45° FOV: 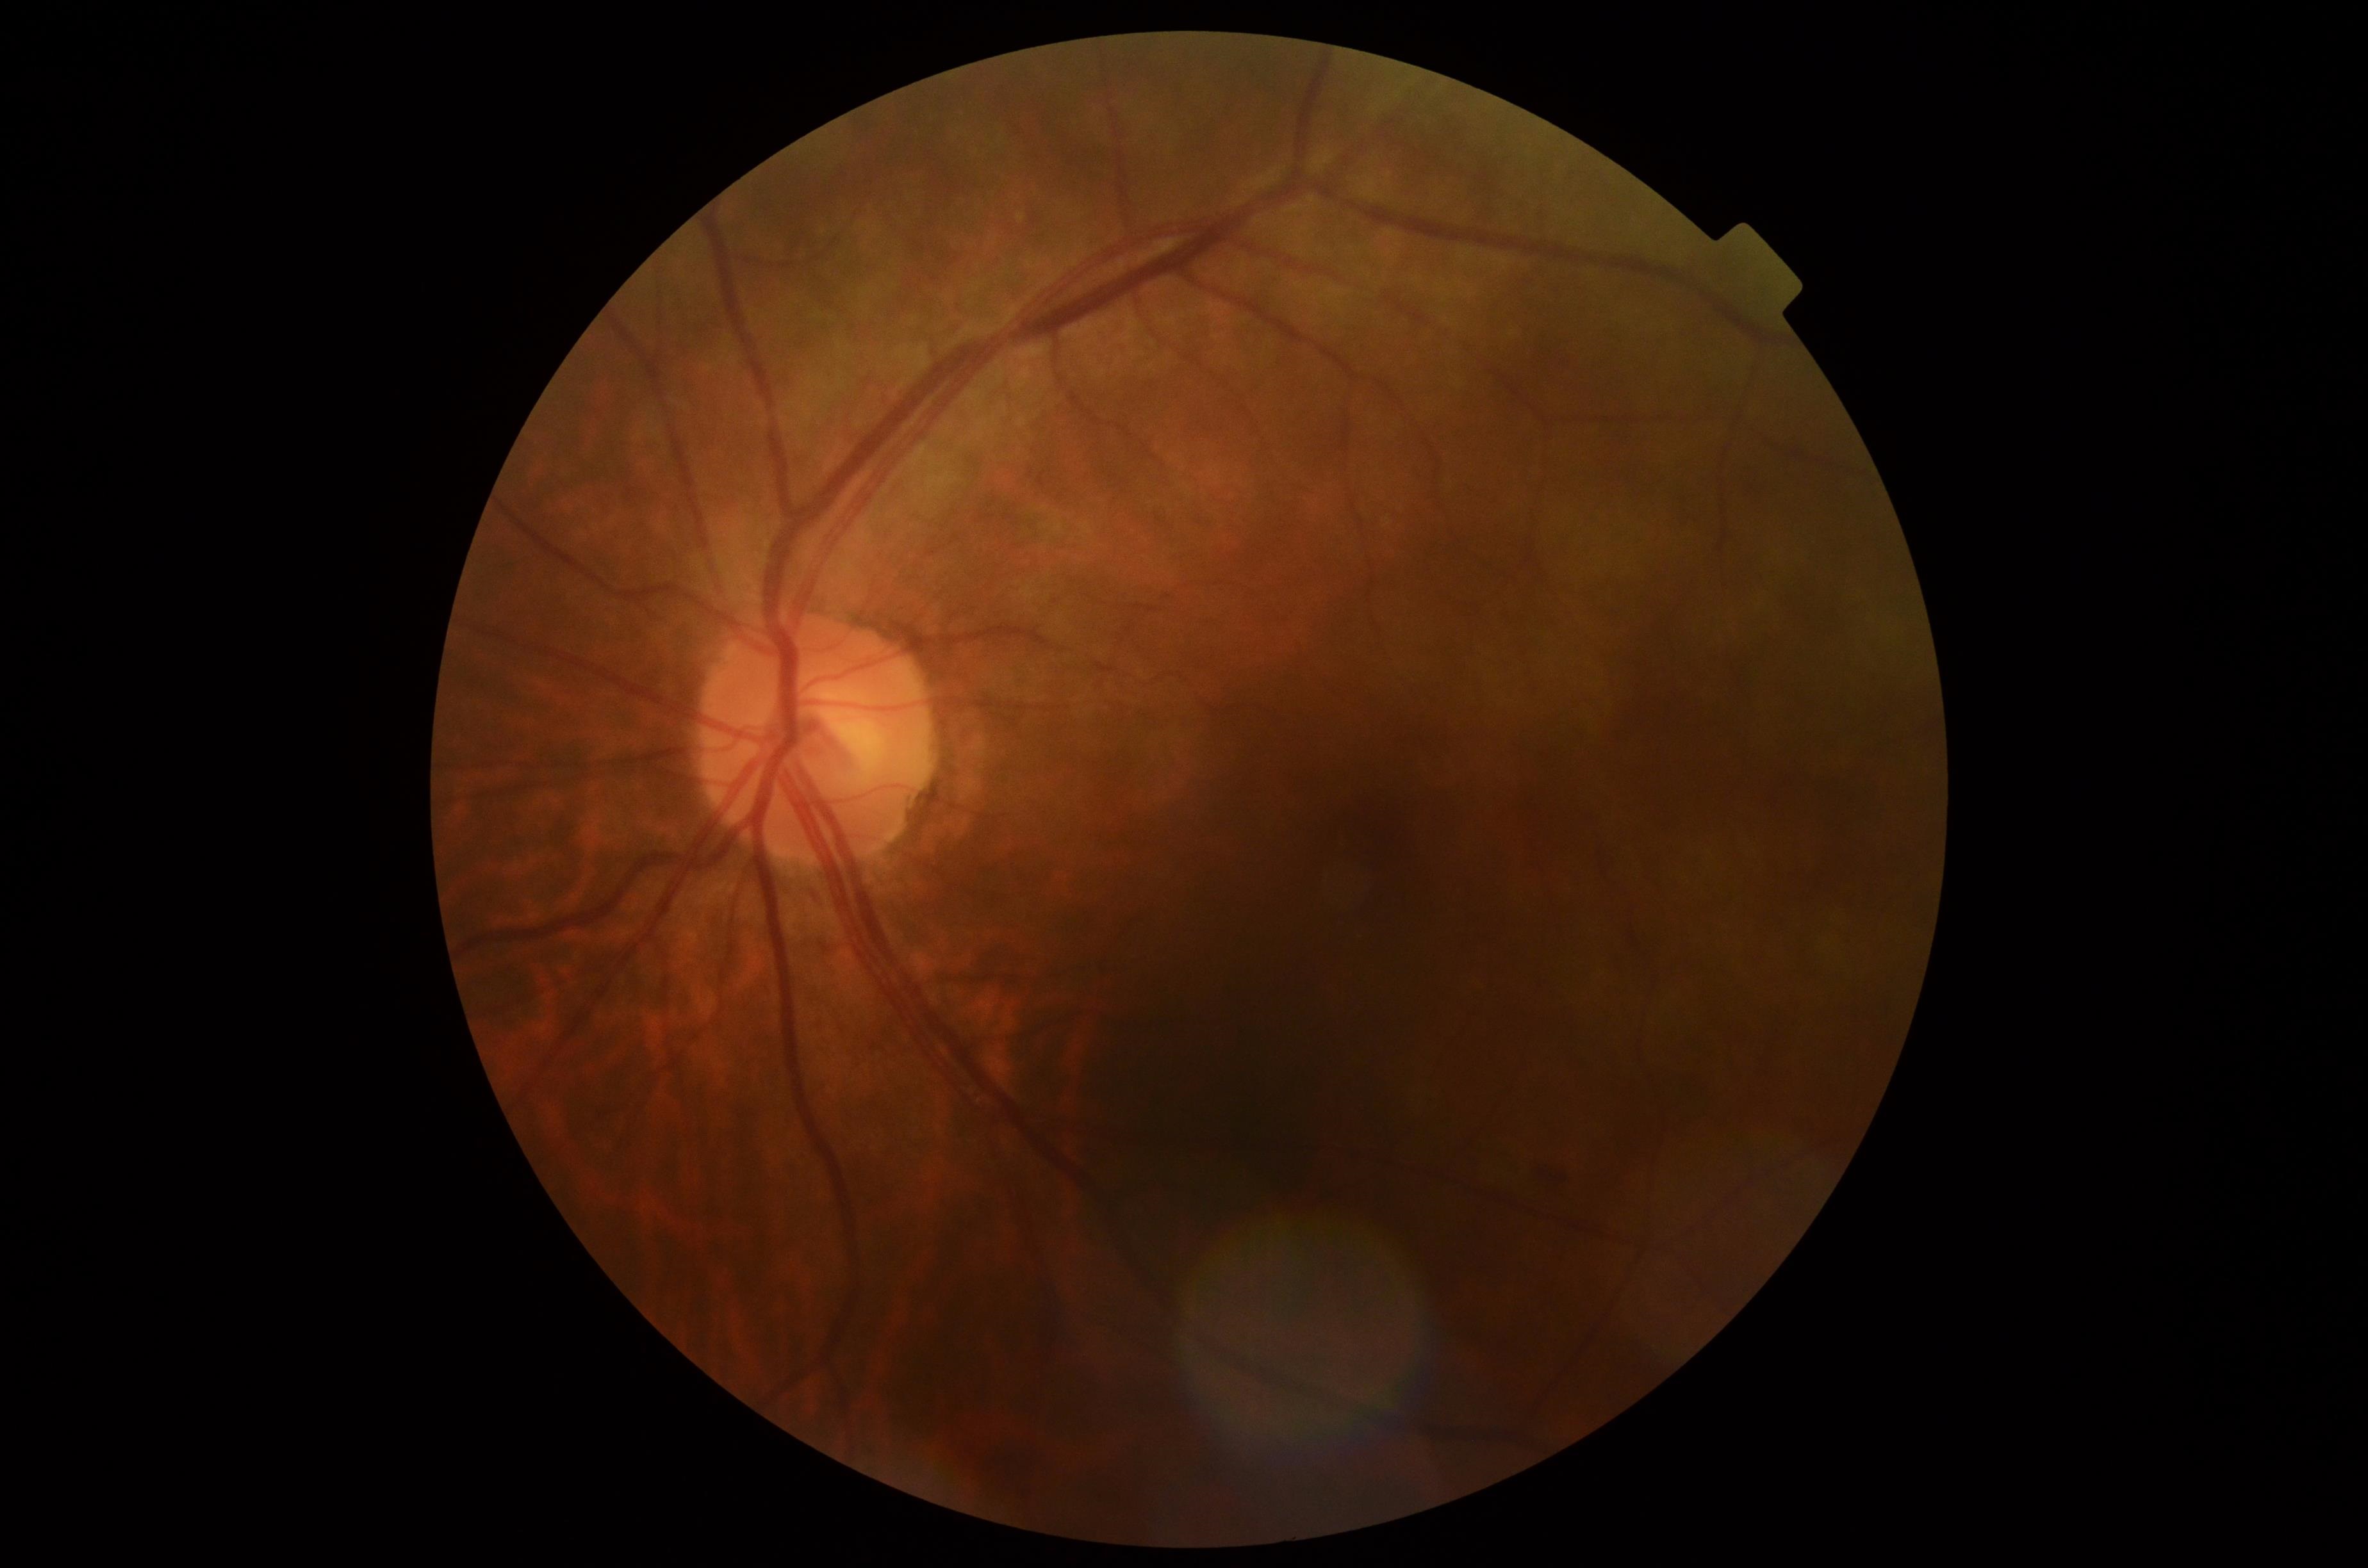

- DR class: non-proliferative diabetic retinopathy
- DR stage: 2/4